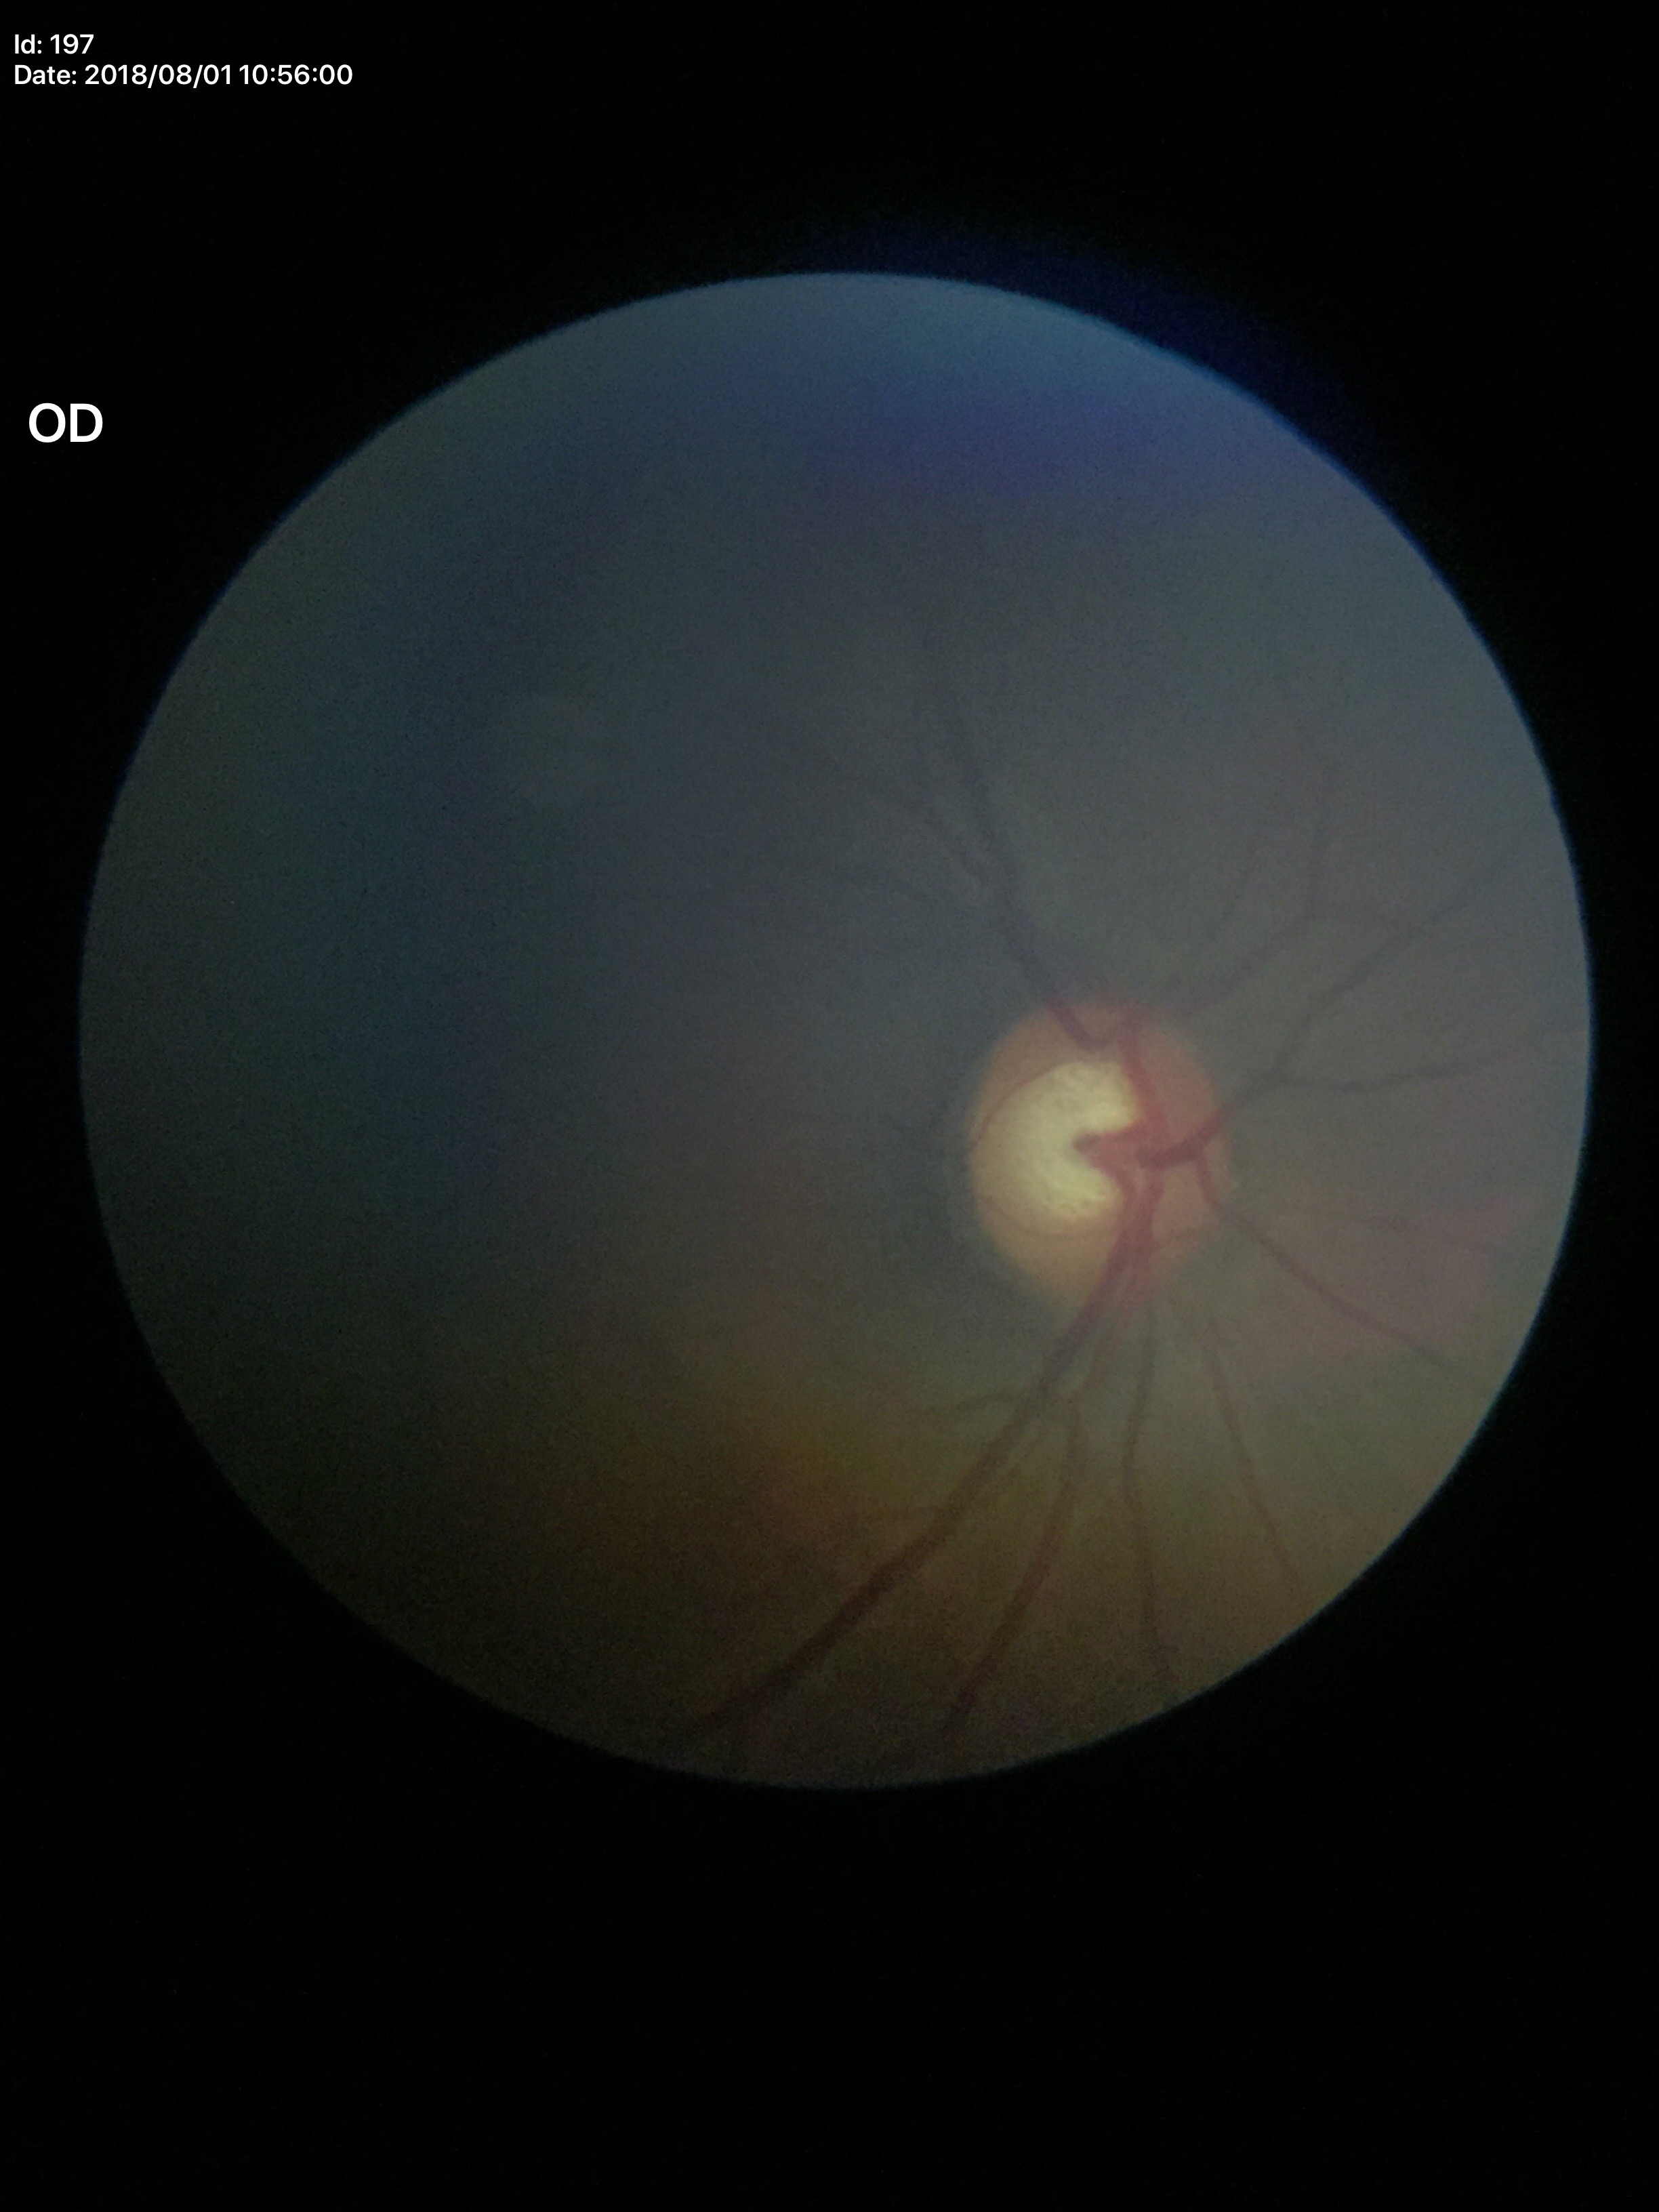 No evidence of glaucoma.
Vertical CDR of 0.58.